2352x1568px.
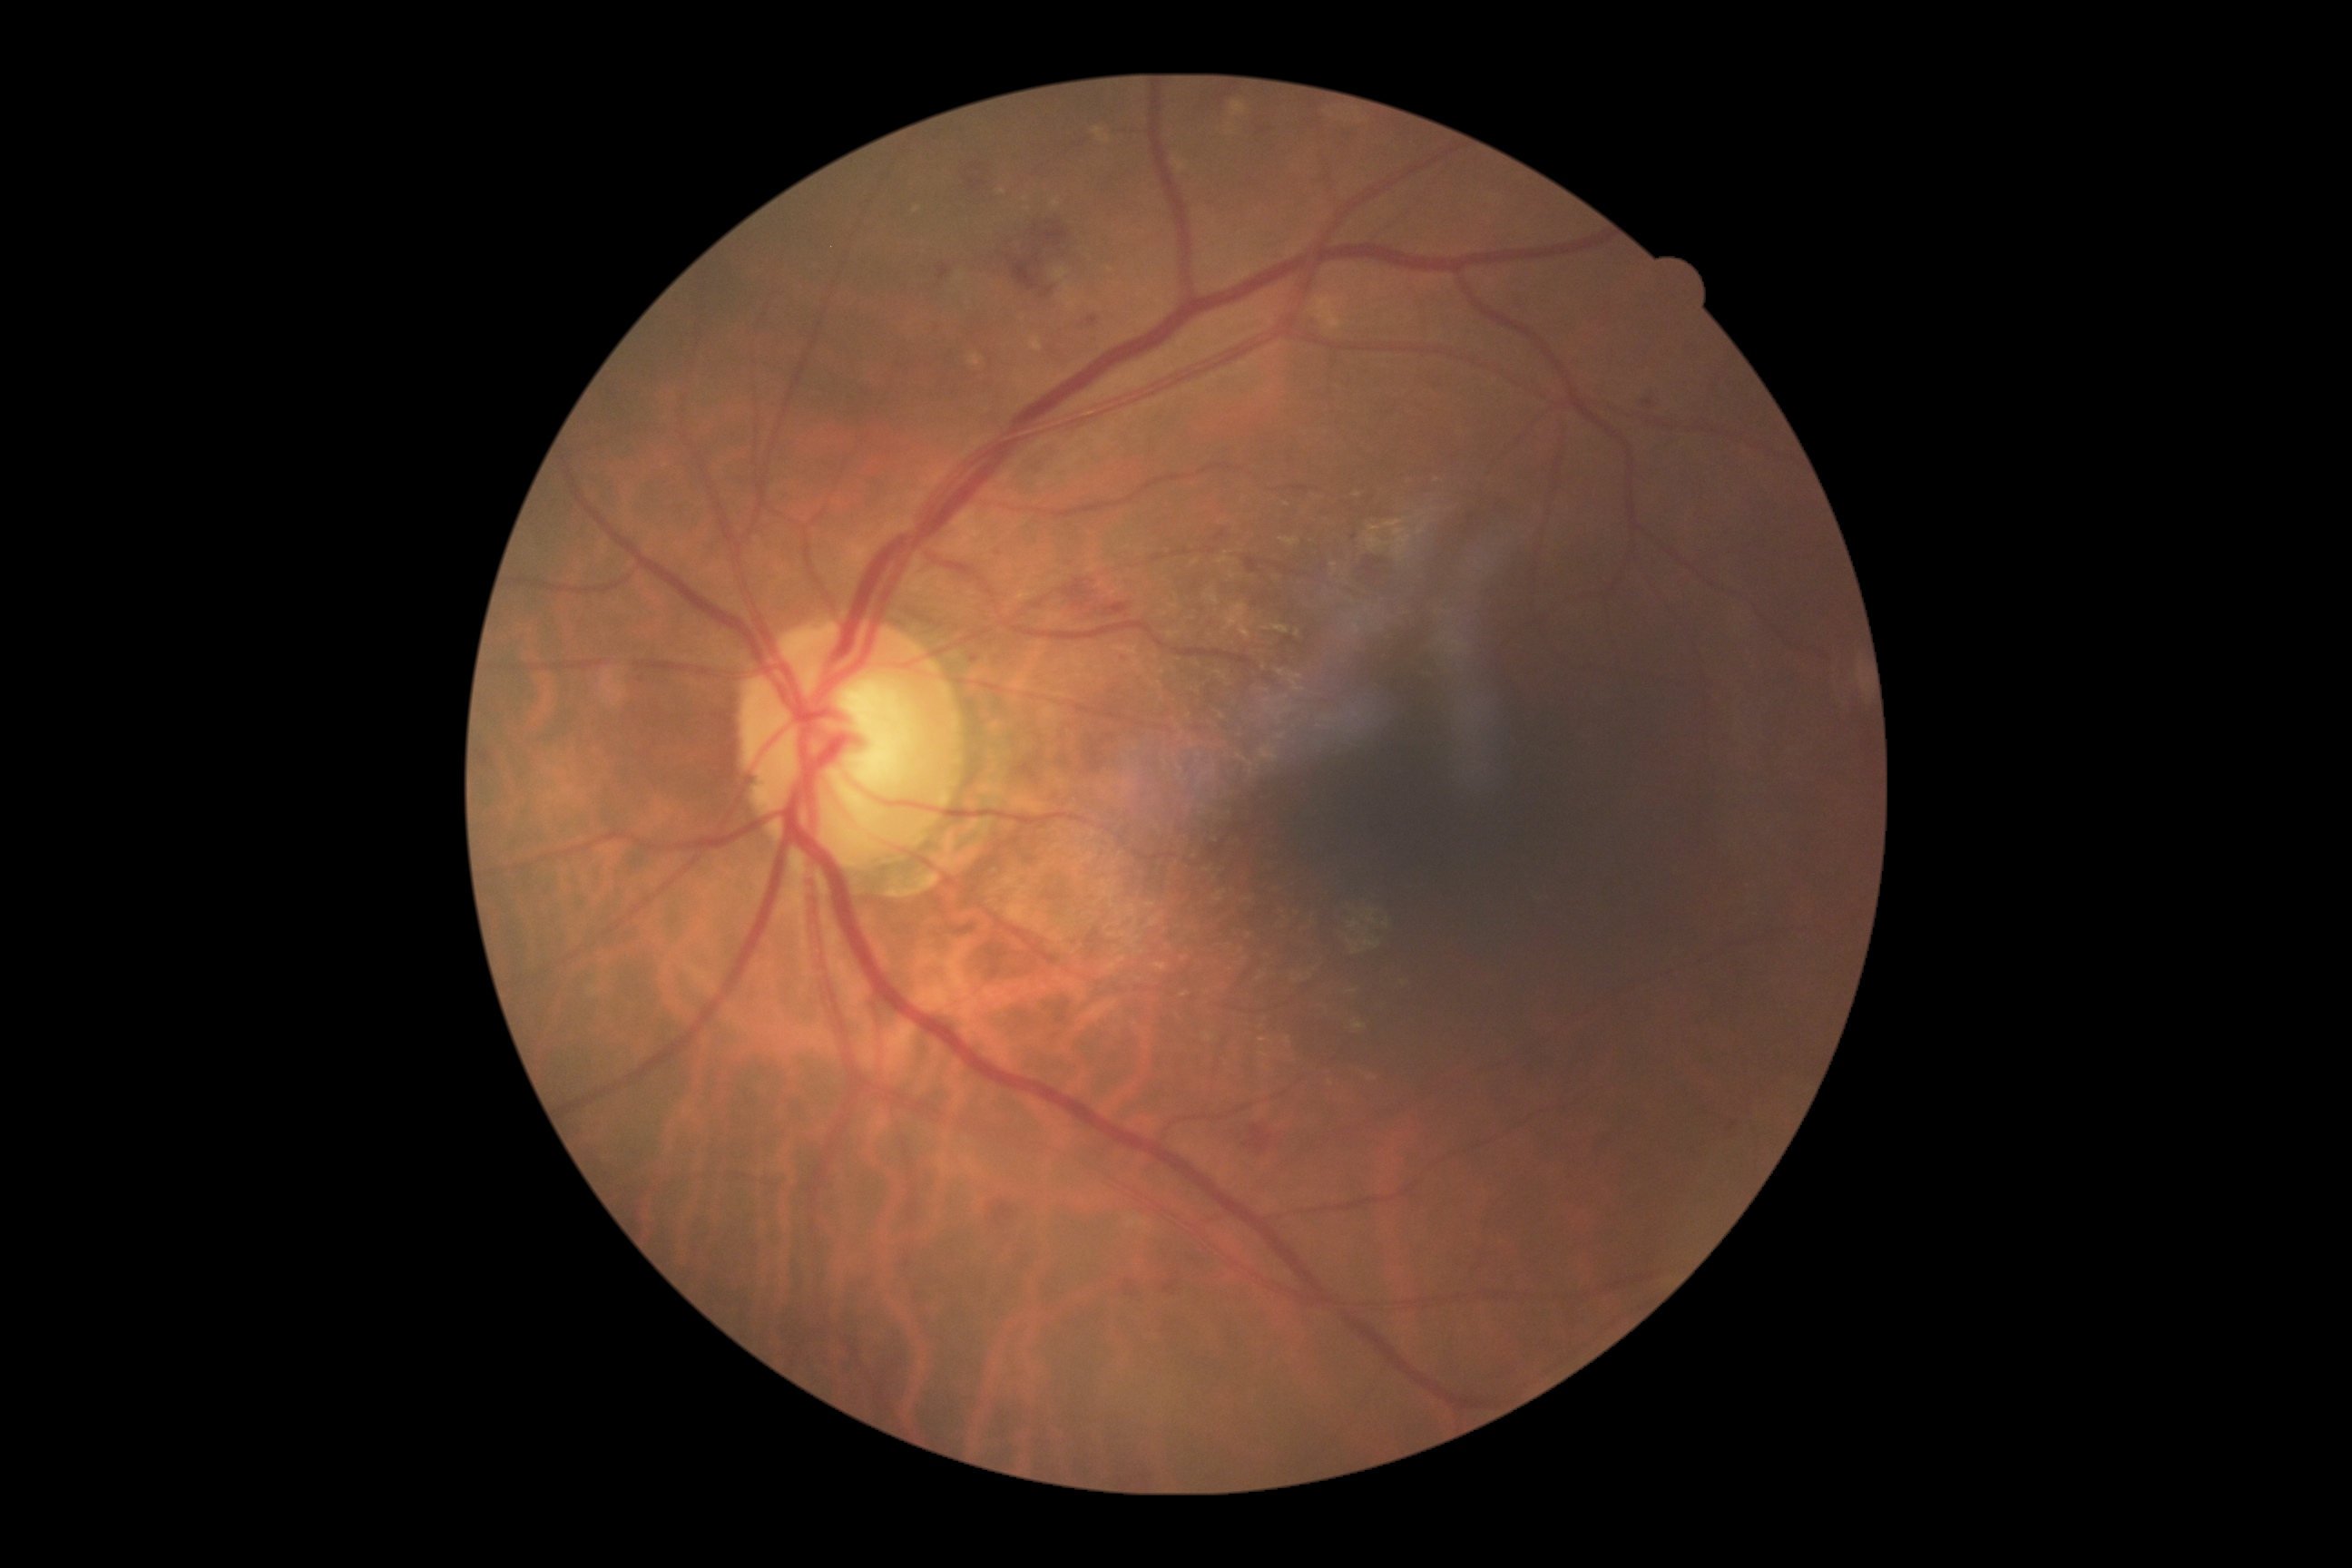
Diabetic retinopathy grade is moderate NPDR (2); non-proliferative diabetic retinopathy
A subset of detected lesions:
* hard exudates (continued): bbox(1416, 511, 1427, 518), bbox(1126, 1215, 1148, 1231), bbox(1260, 749, 1279, 761), bbox(1206, 1035, 1215, 1043), bbox(1024, 208, 1032, 211), bbox(1367, 534, 1384, 553), bbox(1353, 1021, 1367, 1030), bbox(1382, 520, 1413, 558), bbox(1064, 282, 1073, 295), bbox(1030, 338, 1043, 351), bbox(1054, 268, 1068, 280)
* Hard exudates (small, approximate centers) near (1025; 199), (1002; 192)
* soft exudates: not present
* hemorrhages (continued): bbox(990, 1200, 1017, 1228), bbox(480, 750, 493, 767), bbox(1122, 1280, 1135, 1291), bbox(970, 164, 983, 172), bbox(1126, 1293, 1135, 1297), bbox(1643, 400, 1654, 407), bbox(1006, 250, 1055, 299), bbox(965, 179, 986, 193), bbox(1034, 220, 1070, 248), bbox(1362, 556, 1386, 582), bbox(1213, 529, 1226, 542)
* microaneurysms (continued): bbox(1124, 658, 1132, 665), bbox(970, 654, 981, 663), bbox(1246, 558, 1260, 573)
* Microaneurysms (small, approximate centers) near (1354; 537), (642; 679)